Color fundus image; 45° FOV
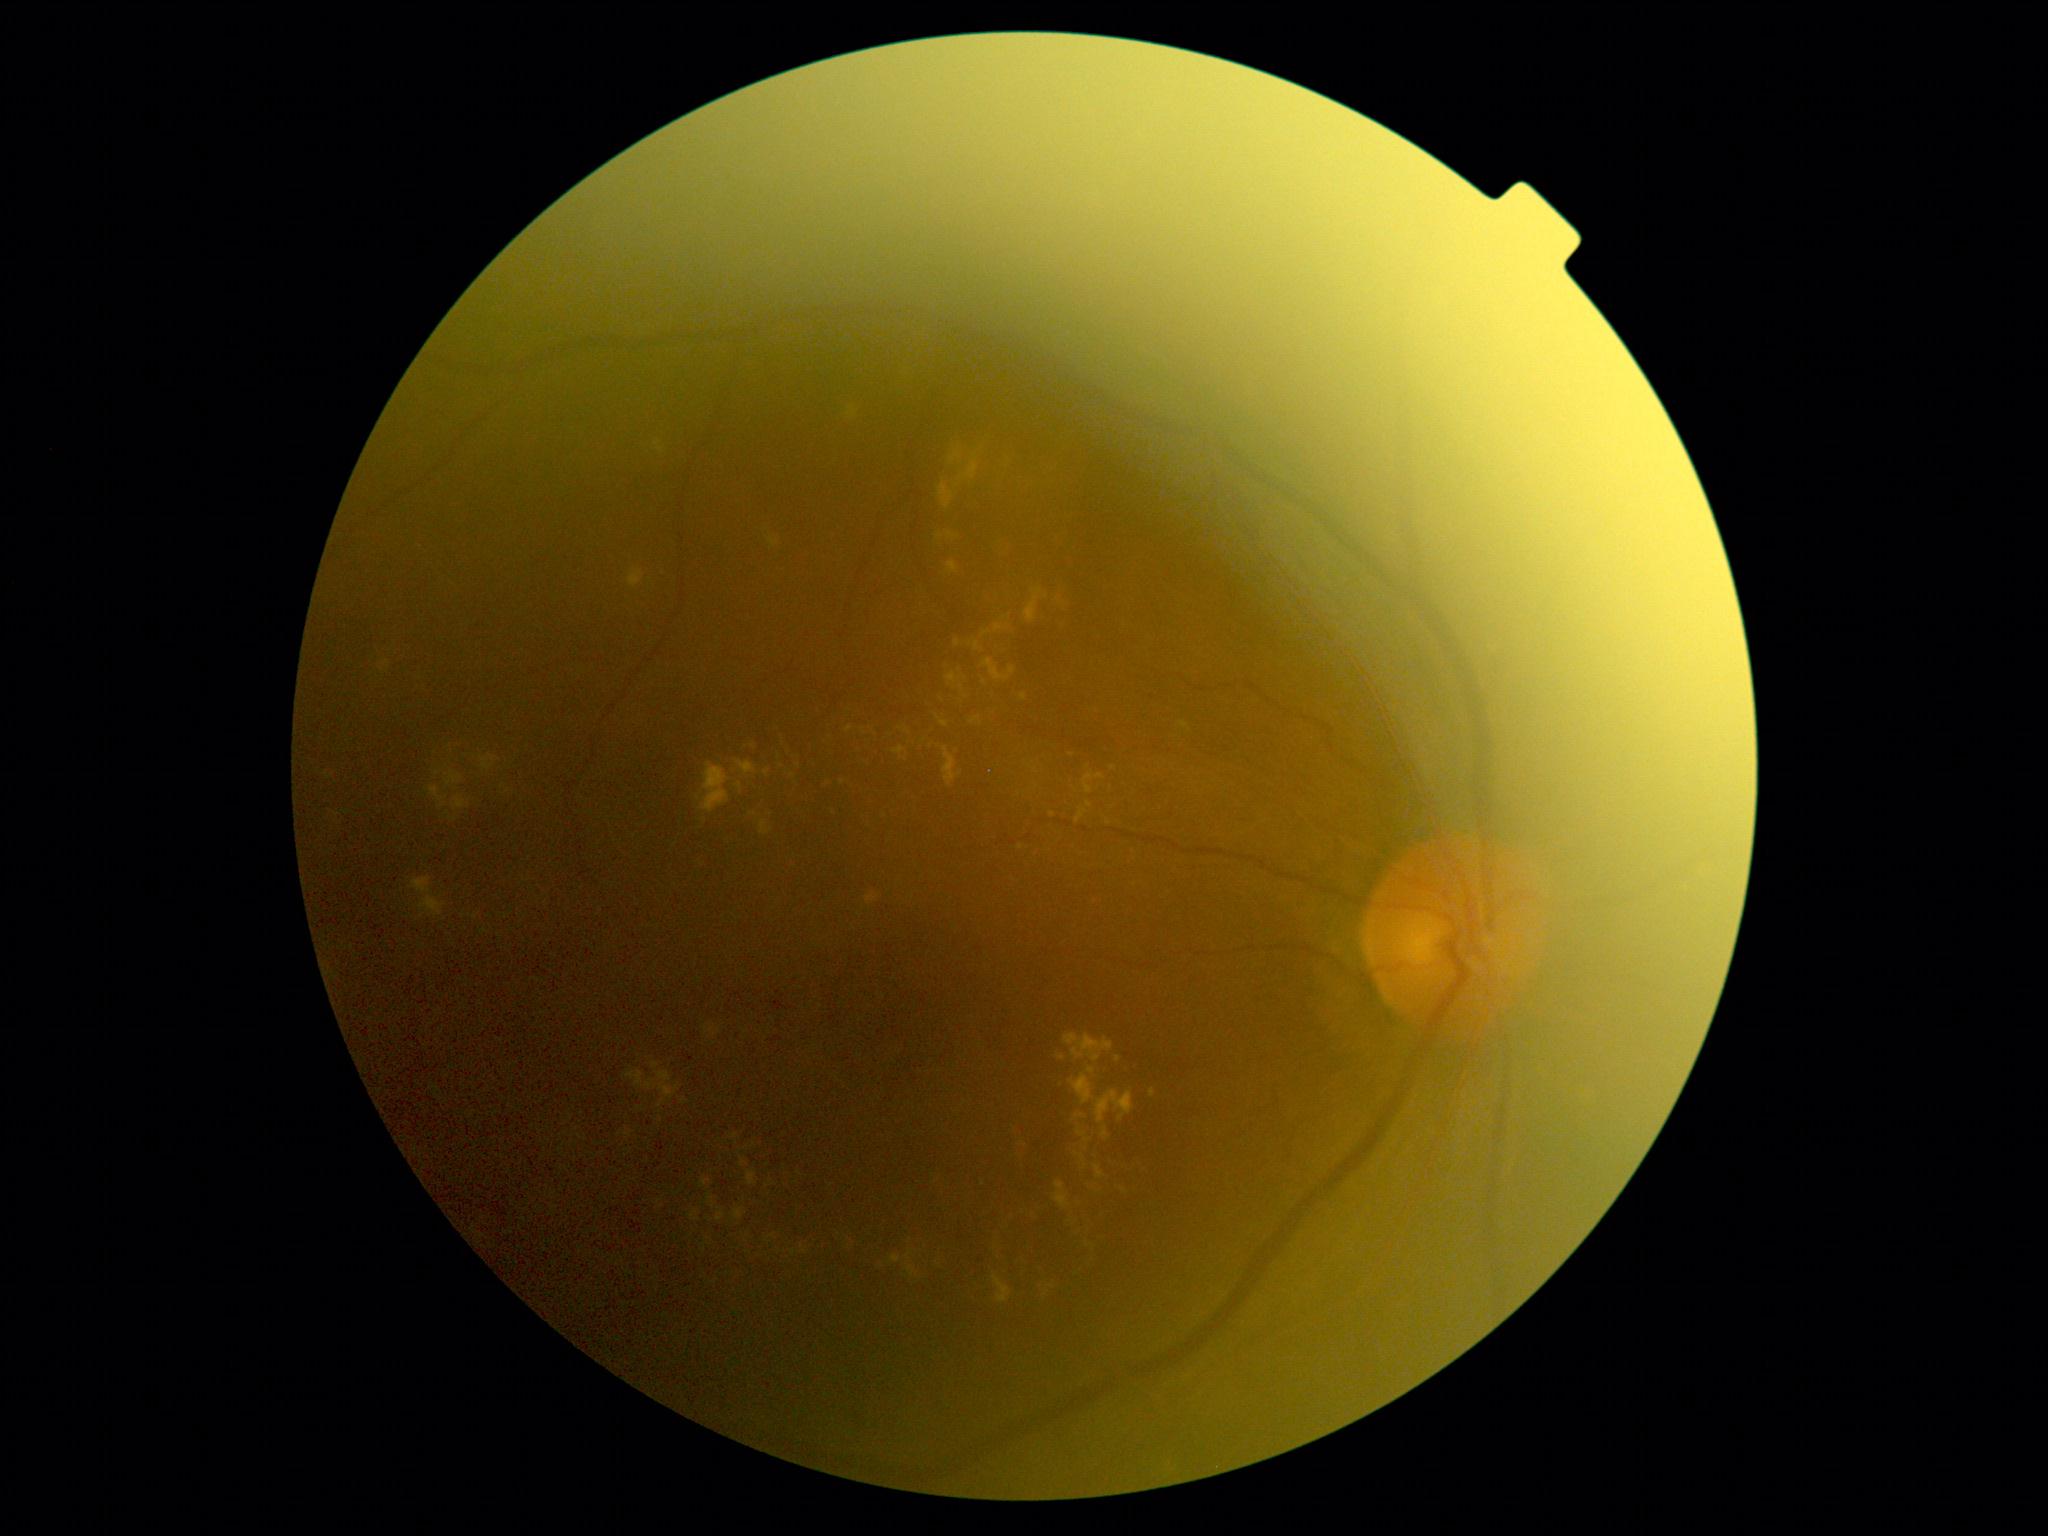
DR severity: moderate non-proliferative diabetic retinopathy (grade 2)
Selected lesions:
EXs (continued): {"left": 948, "top": 561, "right": 959, "bottom": 575}; {"left": 700, "top": 1178, "right": 711, "bottom": 1187}; {"left": 905, "top": 728, "right": 912, "bottom": 736}; {"left": 704, "top": 1024, "right": 721, "bottom": 1037}; {"left": 975, "top": 641, "right": 982, "bottom": 651}; {"left": 737, "top": 737, "right": 754, "bottom": 747}; {"left": 736, "top": 760, "right": 757, "bottom": 776}; {"left": 1064, "top": 1034, "right": 1114, "bottom": 1062}; {"left": 1009, "top": 1122, "right": 1026, "bottom": 1167}; {"left": 955, "top": 640, "right": 961, "bottom": 648}; {"left": 946, "top": 532, "right": 959, "bottom": 541}; {"left": 736, "top": 783, "right": 743, "bottom": 794}; {"left": 746, "top": 799, "right": 774, "bottom": 817}
Additional small EXs near {"x": 772, "y": 1236}; {"x": 1053, "y": 815}; {"x": 800, "y": 1174}; {"x": 864, "y": 732}; {"x": 938, "y": 717}; {"x": 438, "y": 773}; {"x": 1099, "y": 1191}